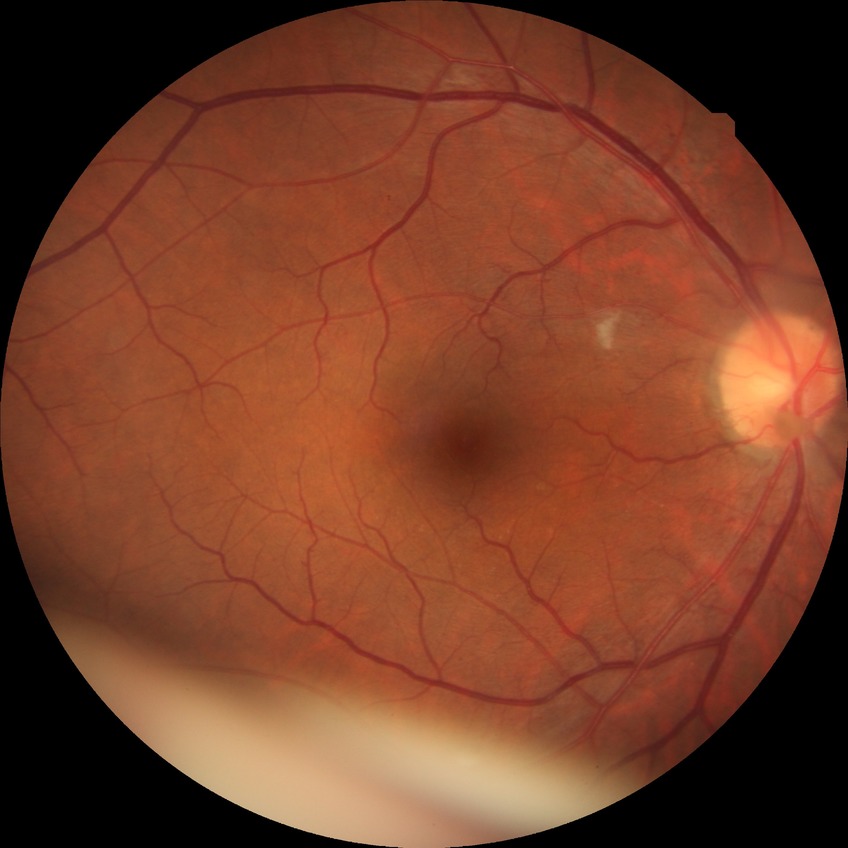

Diabetic retinopathy grade: pre-proliferative diabetic retinopathy.